45-degree field of view · 2346 x 1568 pixels · retinal fundus photograph
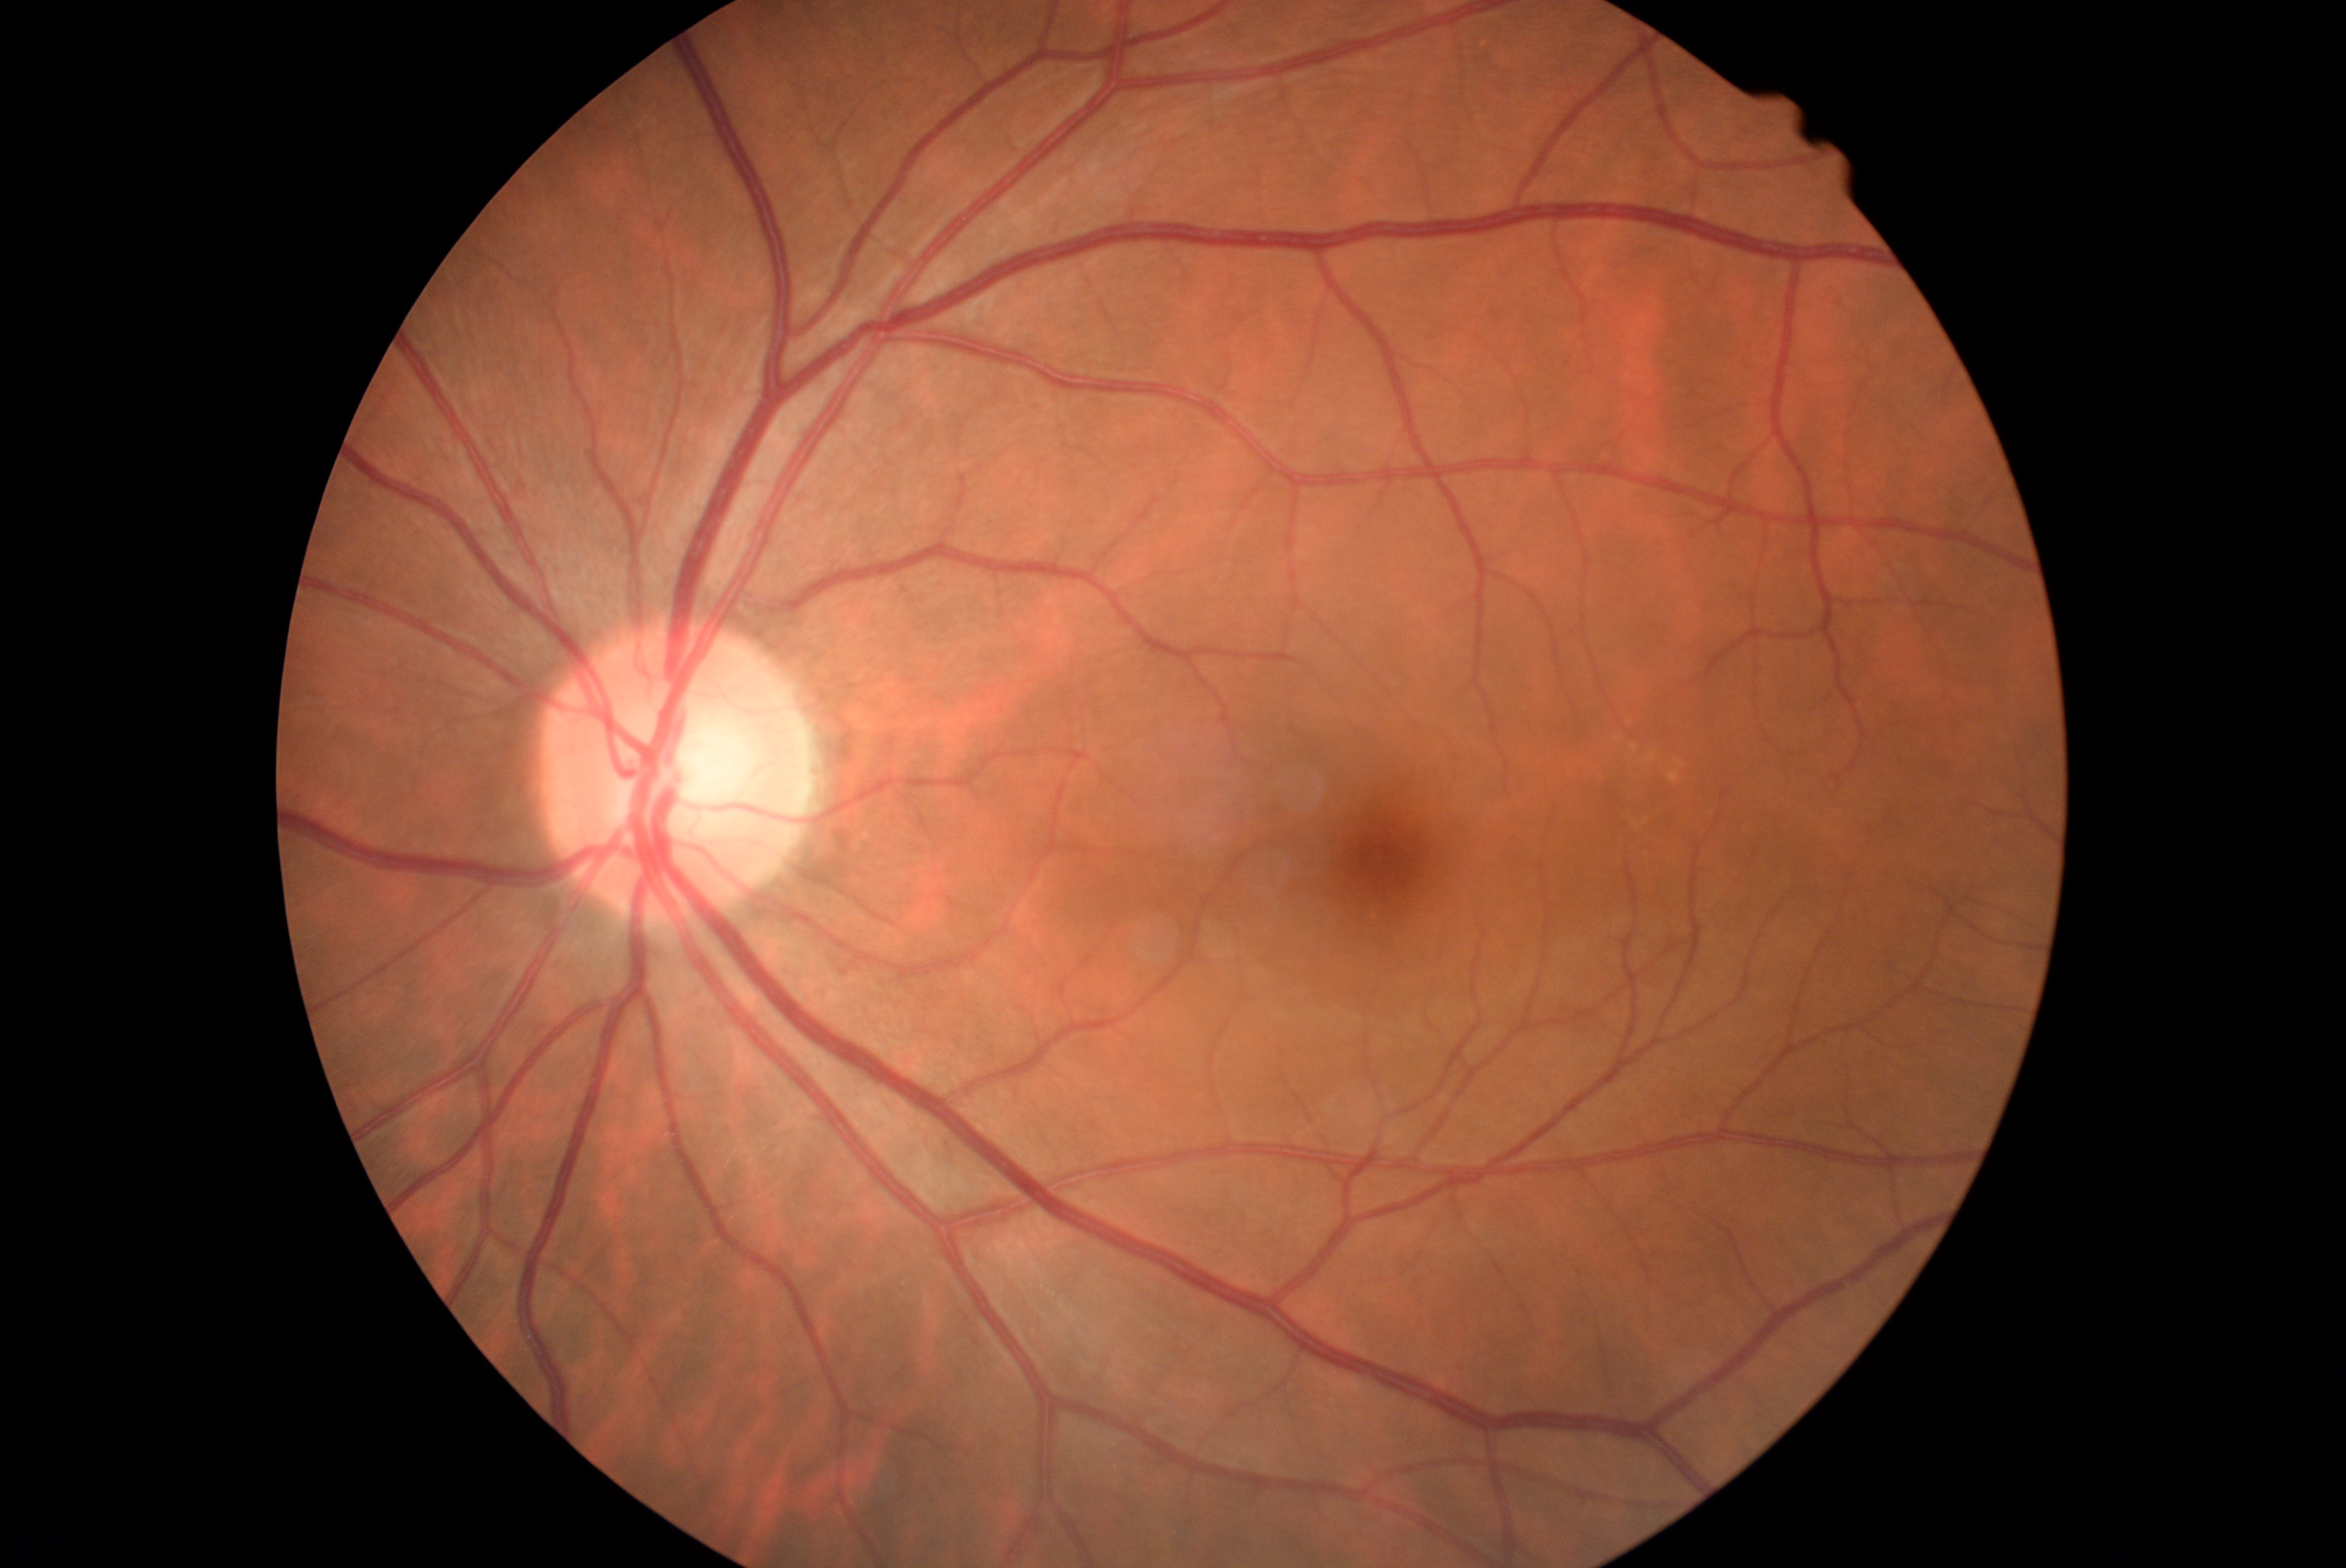

Annotations:
• DR grade — 0